848 x 848 pixels. Graded on the modified Davis scale. NIDEK AFC-230. No pharmacologic dilation. 45-degree field of view — 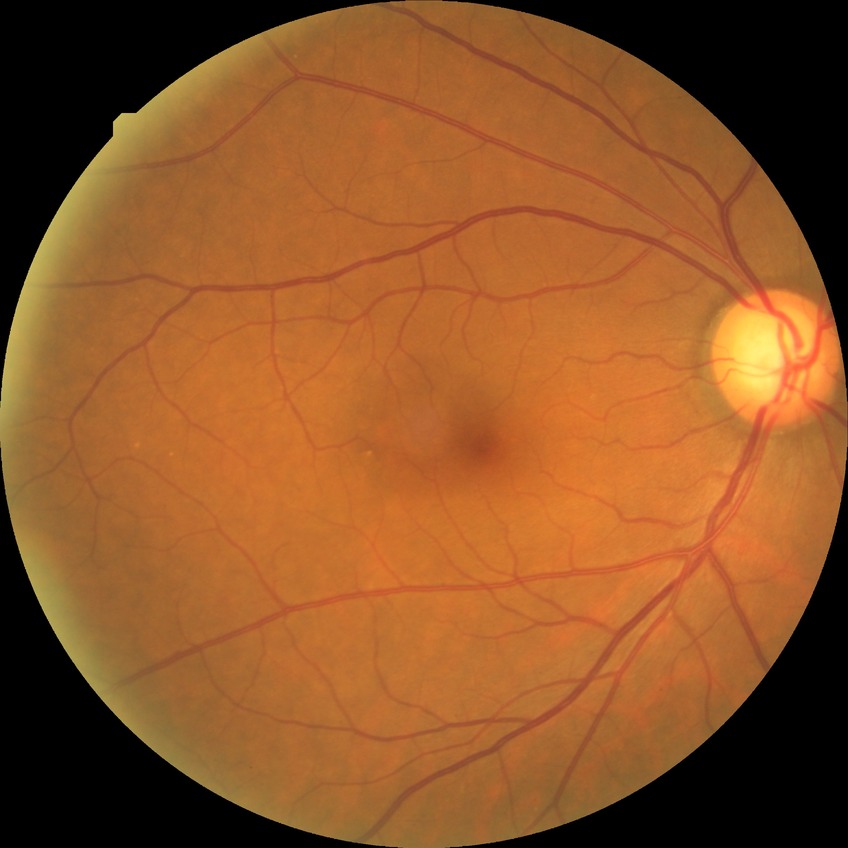
diabetic retinopathy (DR): no diabetic retinopathy (NDR).